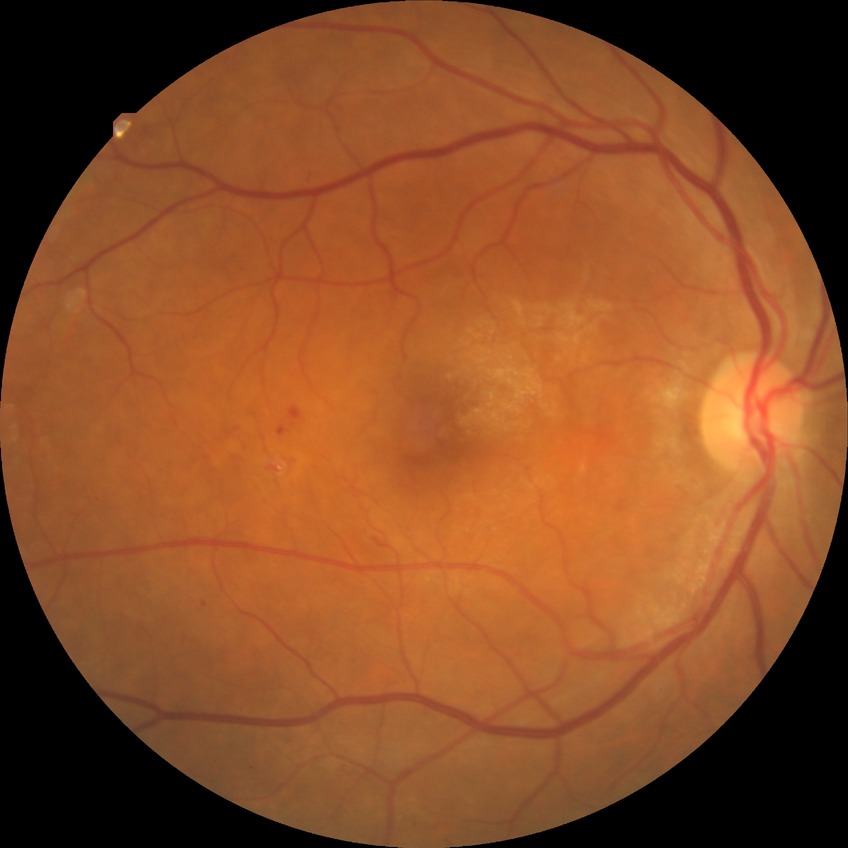

Diabetic retinopathy severity is simple diabetic retinopathy.